CFP:
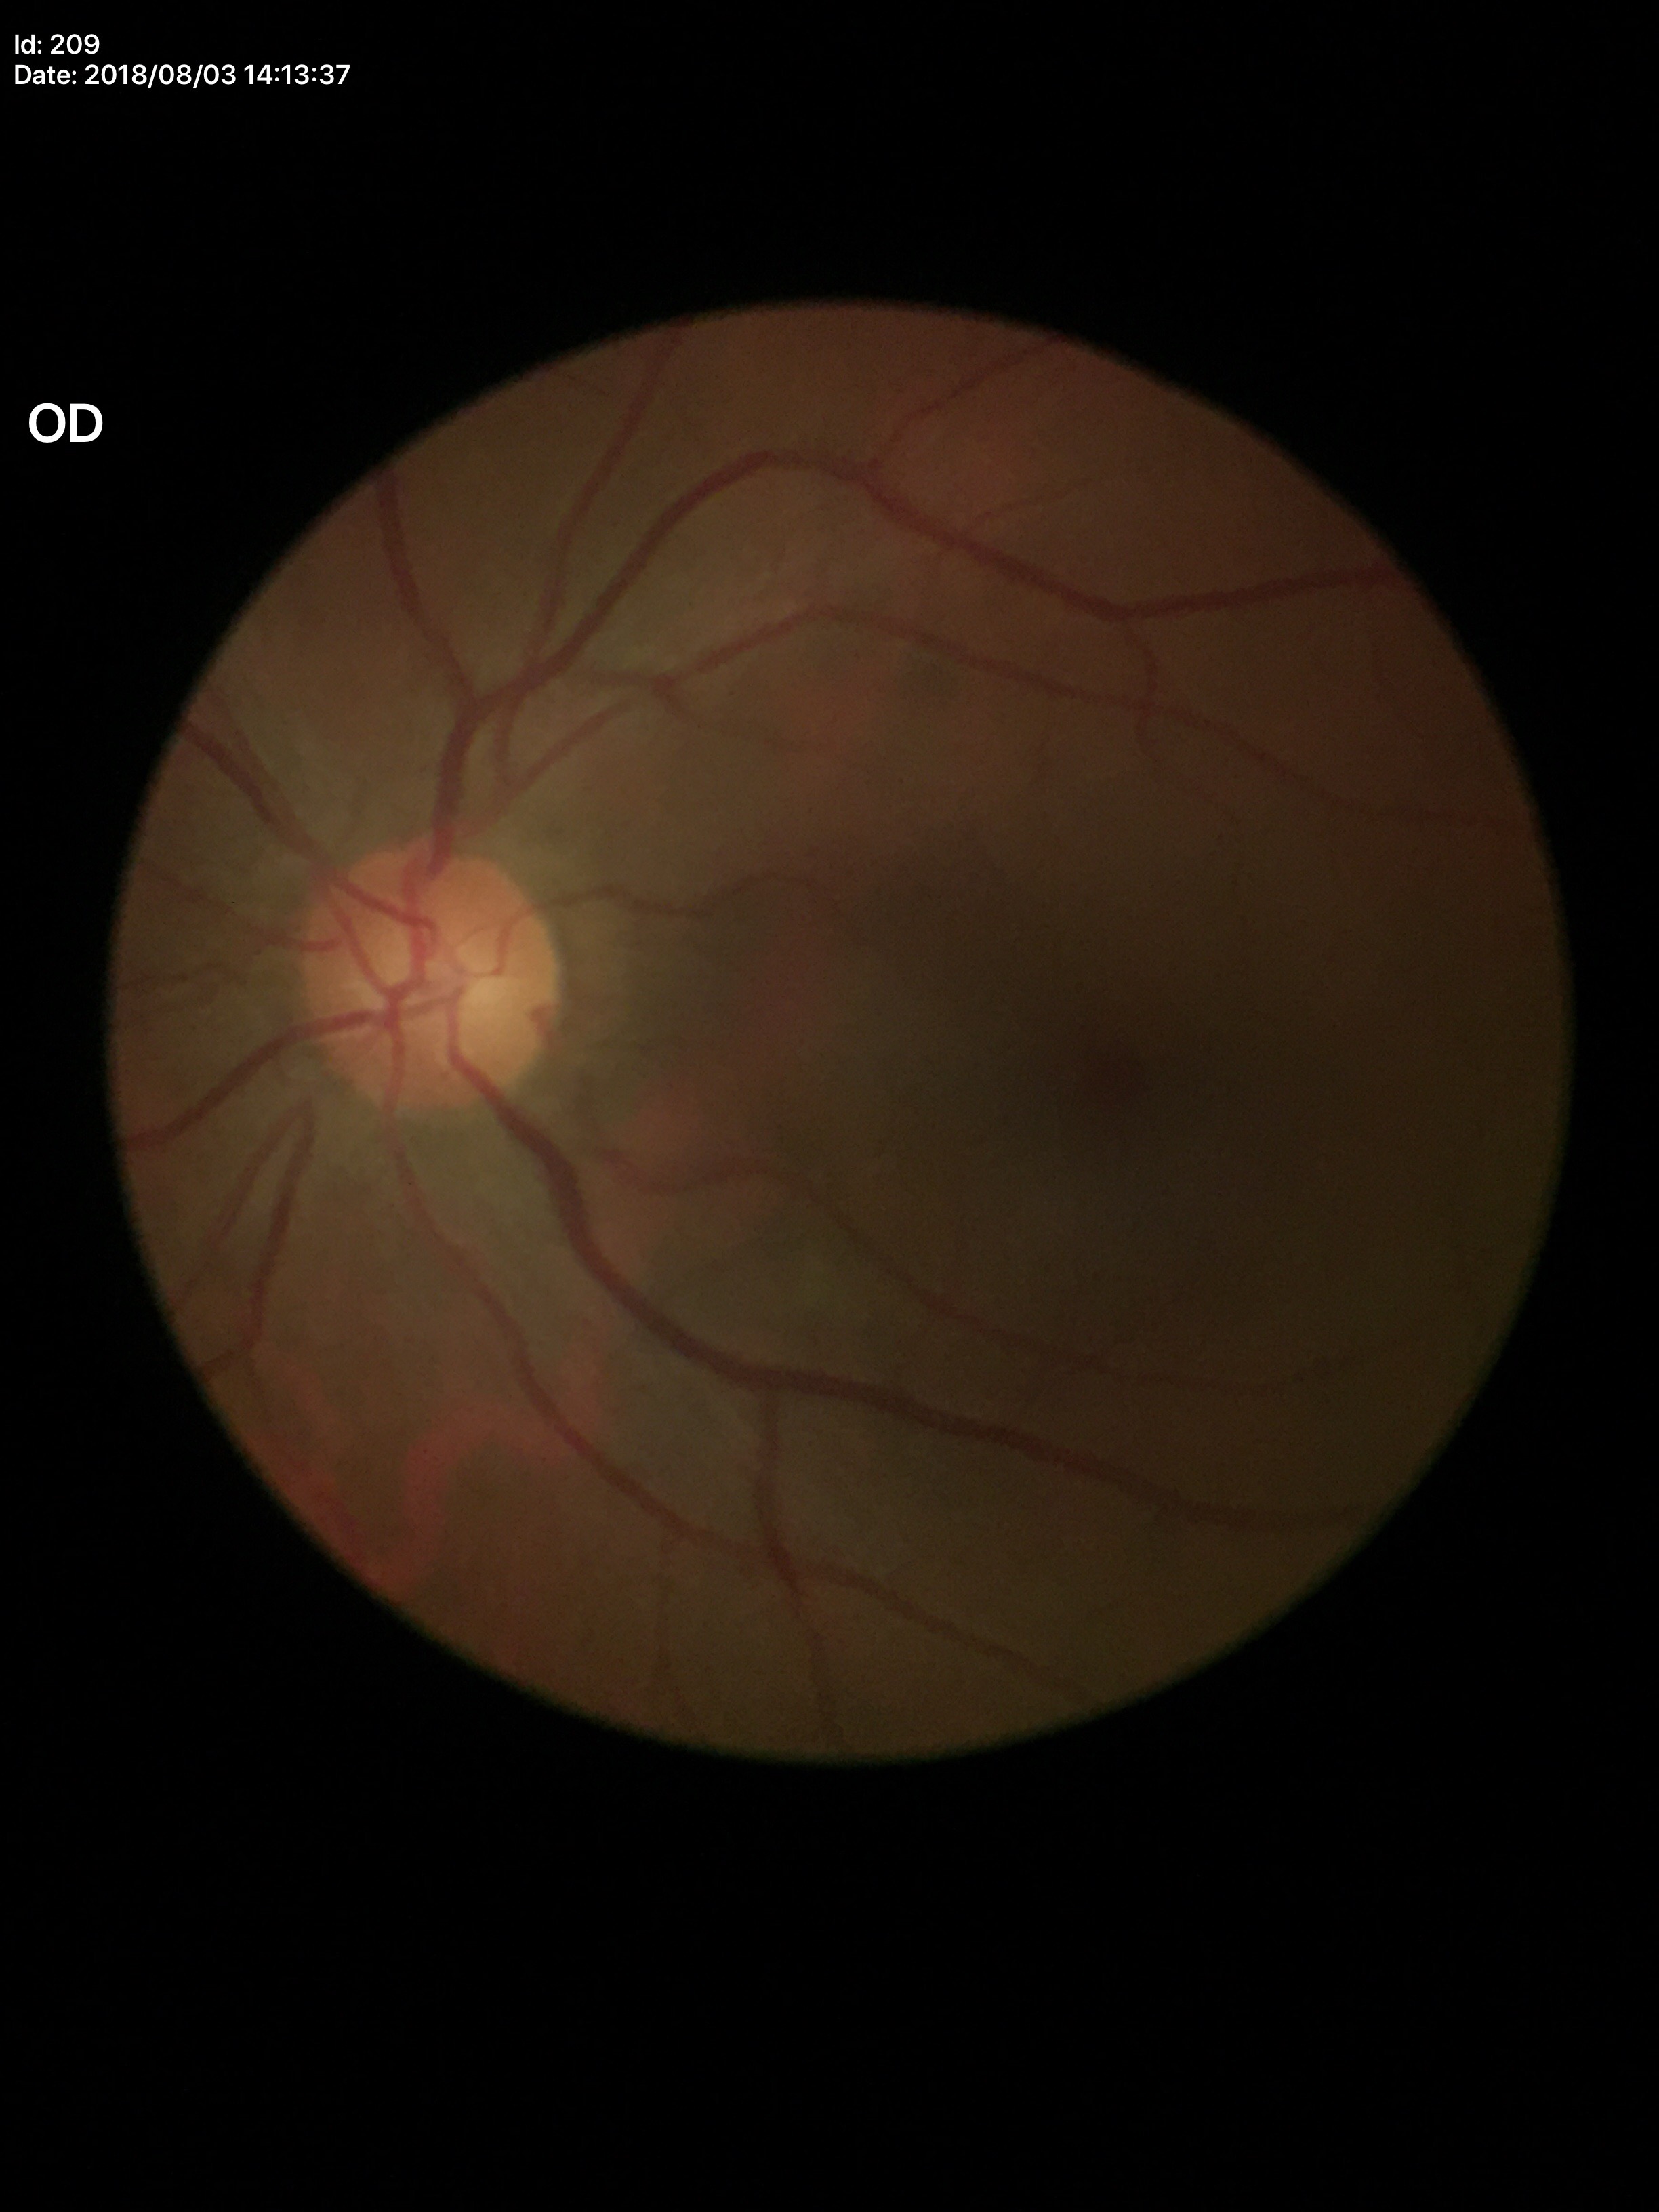

{
  "glaucoma_decision": "not suspect",
  "vcdr": "0.44",
  "acdr": "0.21"
}